Acquired with a NIDEK AFC-230. 45-degree field of view — 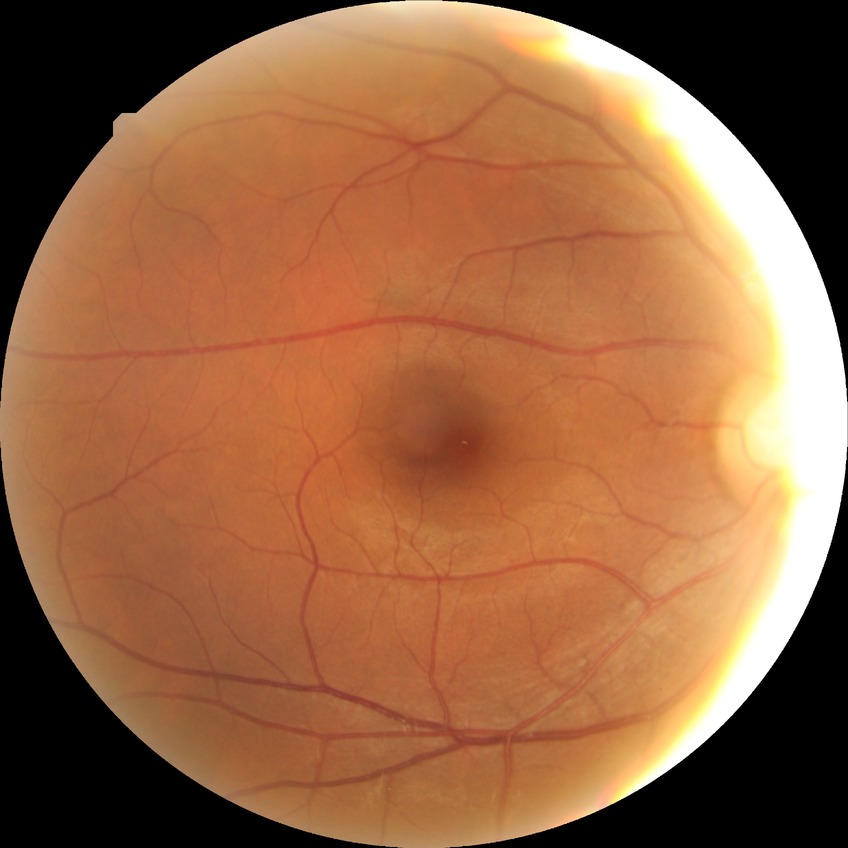
Diabetic retinopathy (DR): NDR (no diabetic retinopathy).